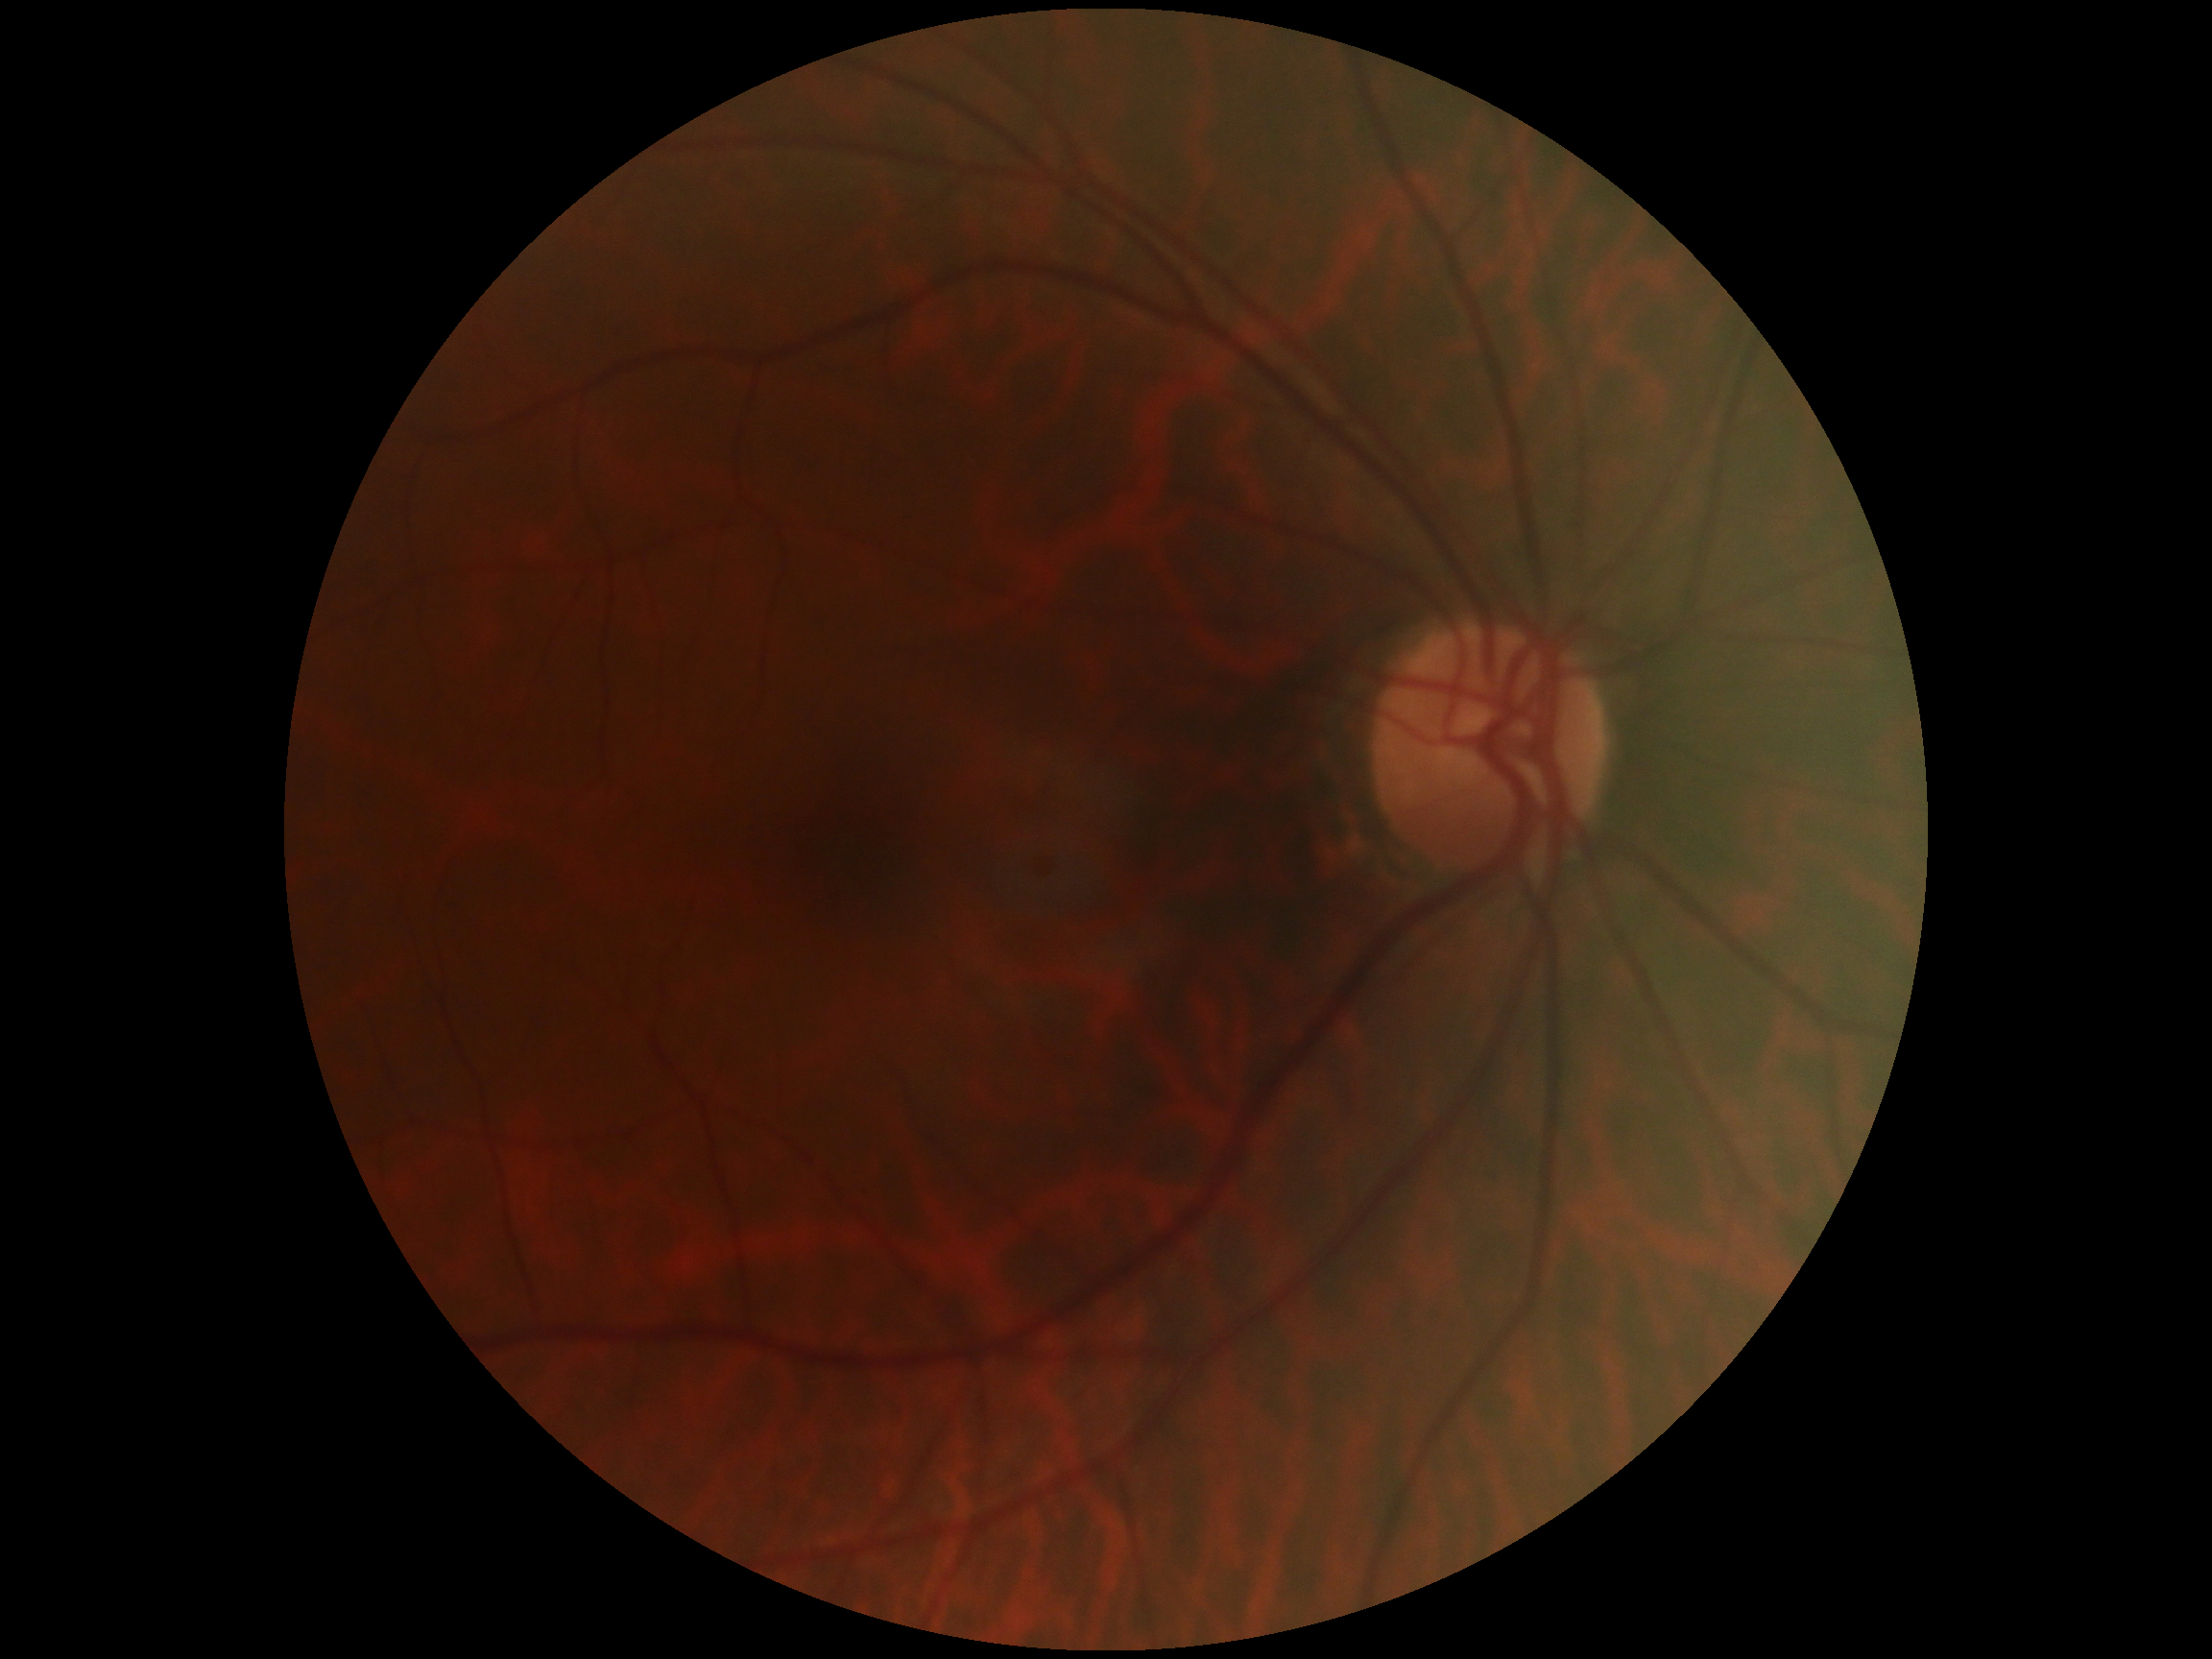 Diabetic retinopathy severity is no apparent diabetic retinopathy (grade 0).
No DR findings.